Infant wide-field fundus photograph: 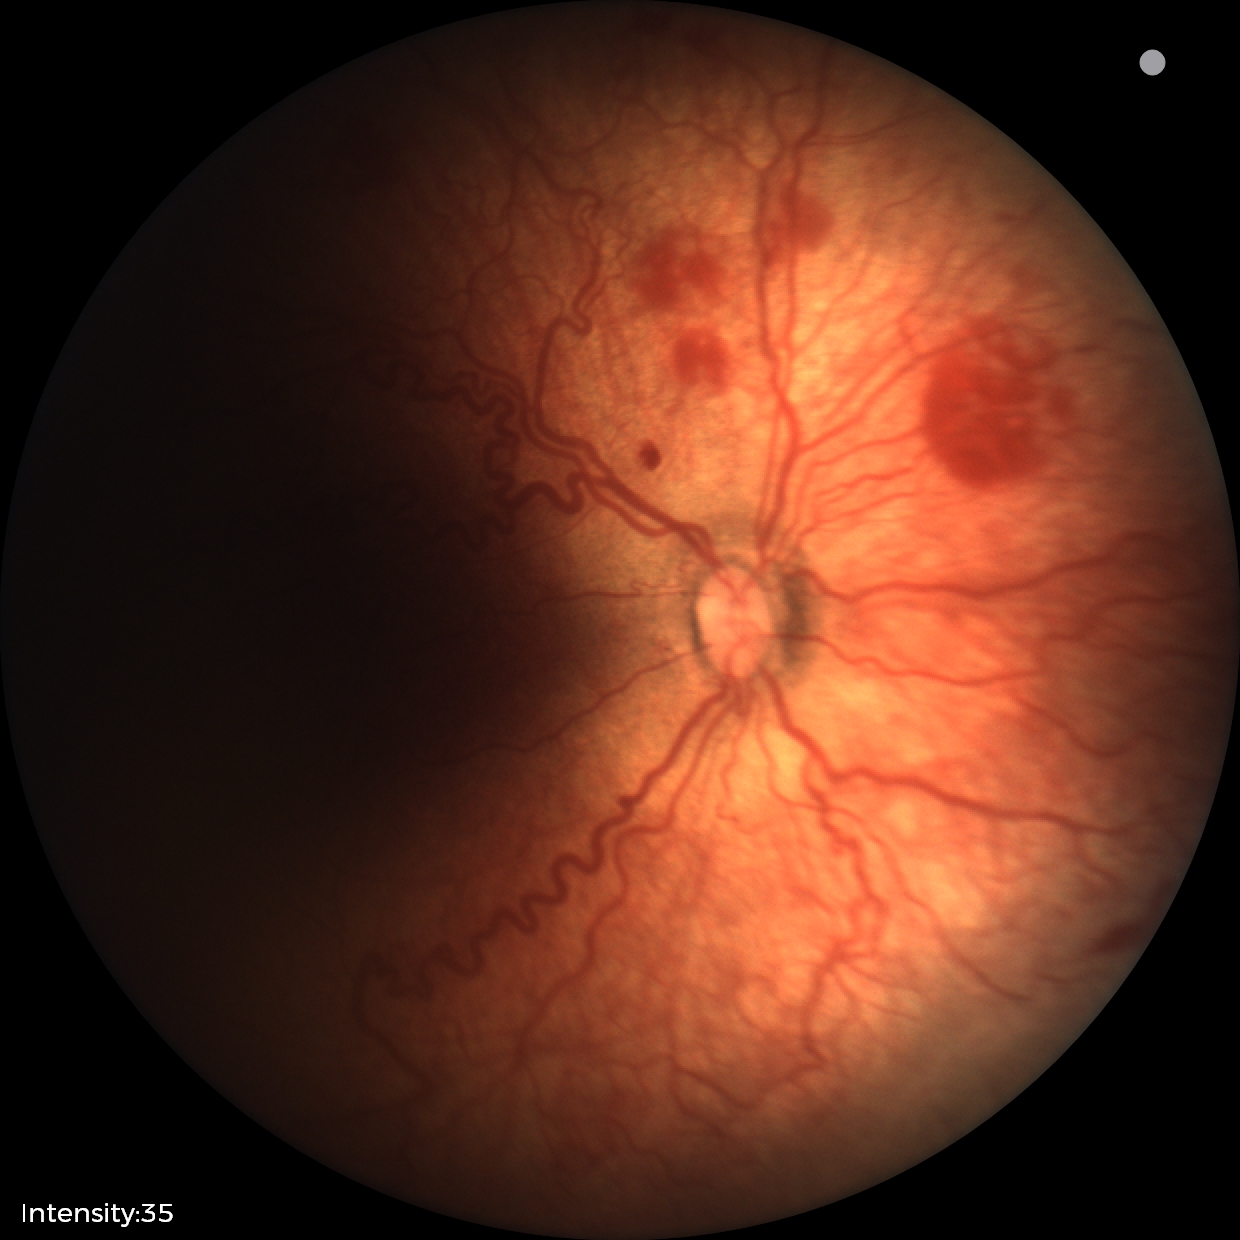

Q: What is the diagnosis from this examination?
A: retinopathy of prematurity (ROP) stage 2